Posterior pole color fundus photograph.
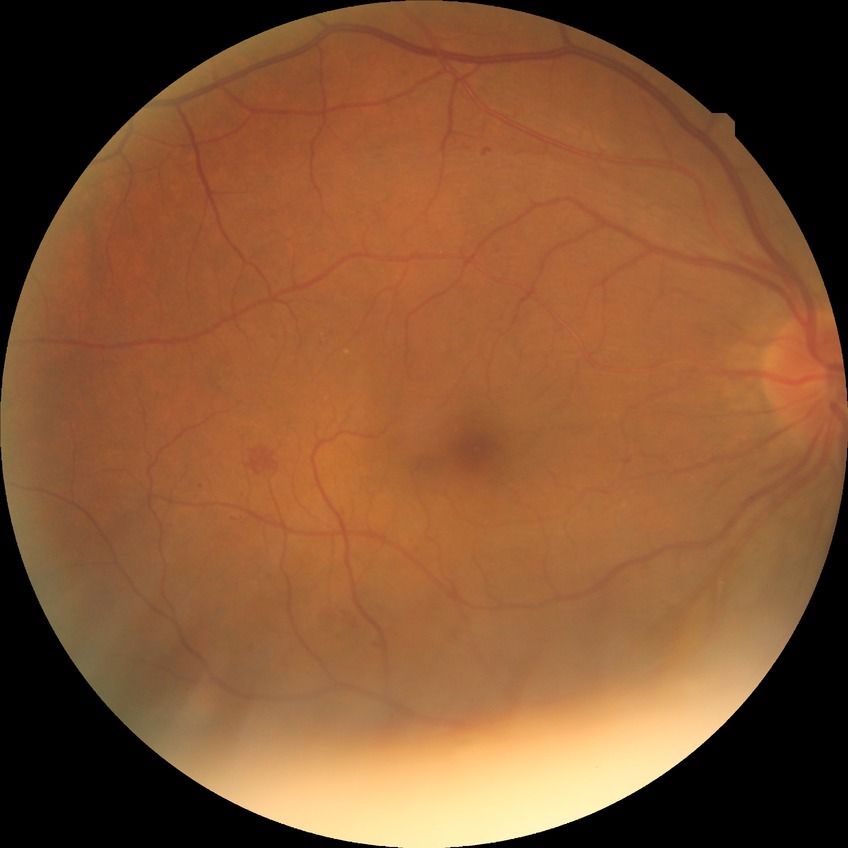

Diabetic retinopathy (DR) is simple diabetic retinopathy (SDR).